Captured with the Clarity RetCam 3 (130° field of view) · 640 x 480 pixels · wide-field contact fundus photograph of an infant.
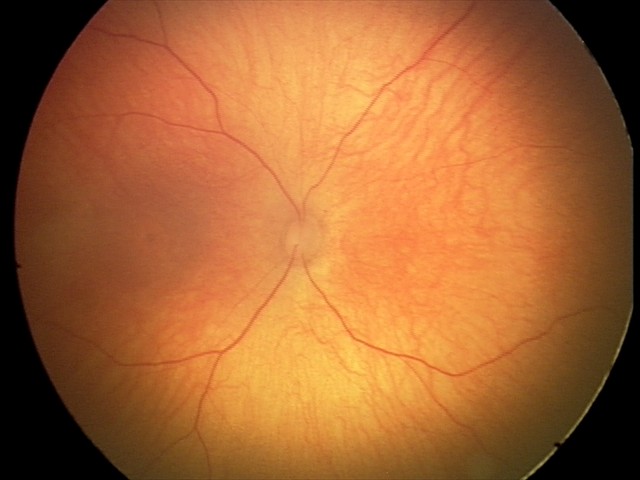
Screening examination diagnosed as physiological.